45° field of view: 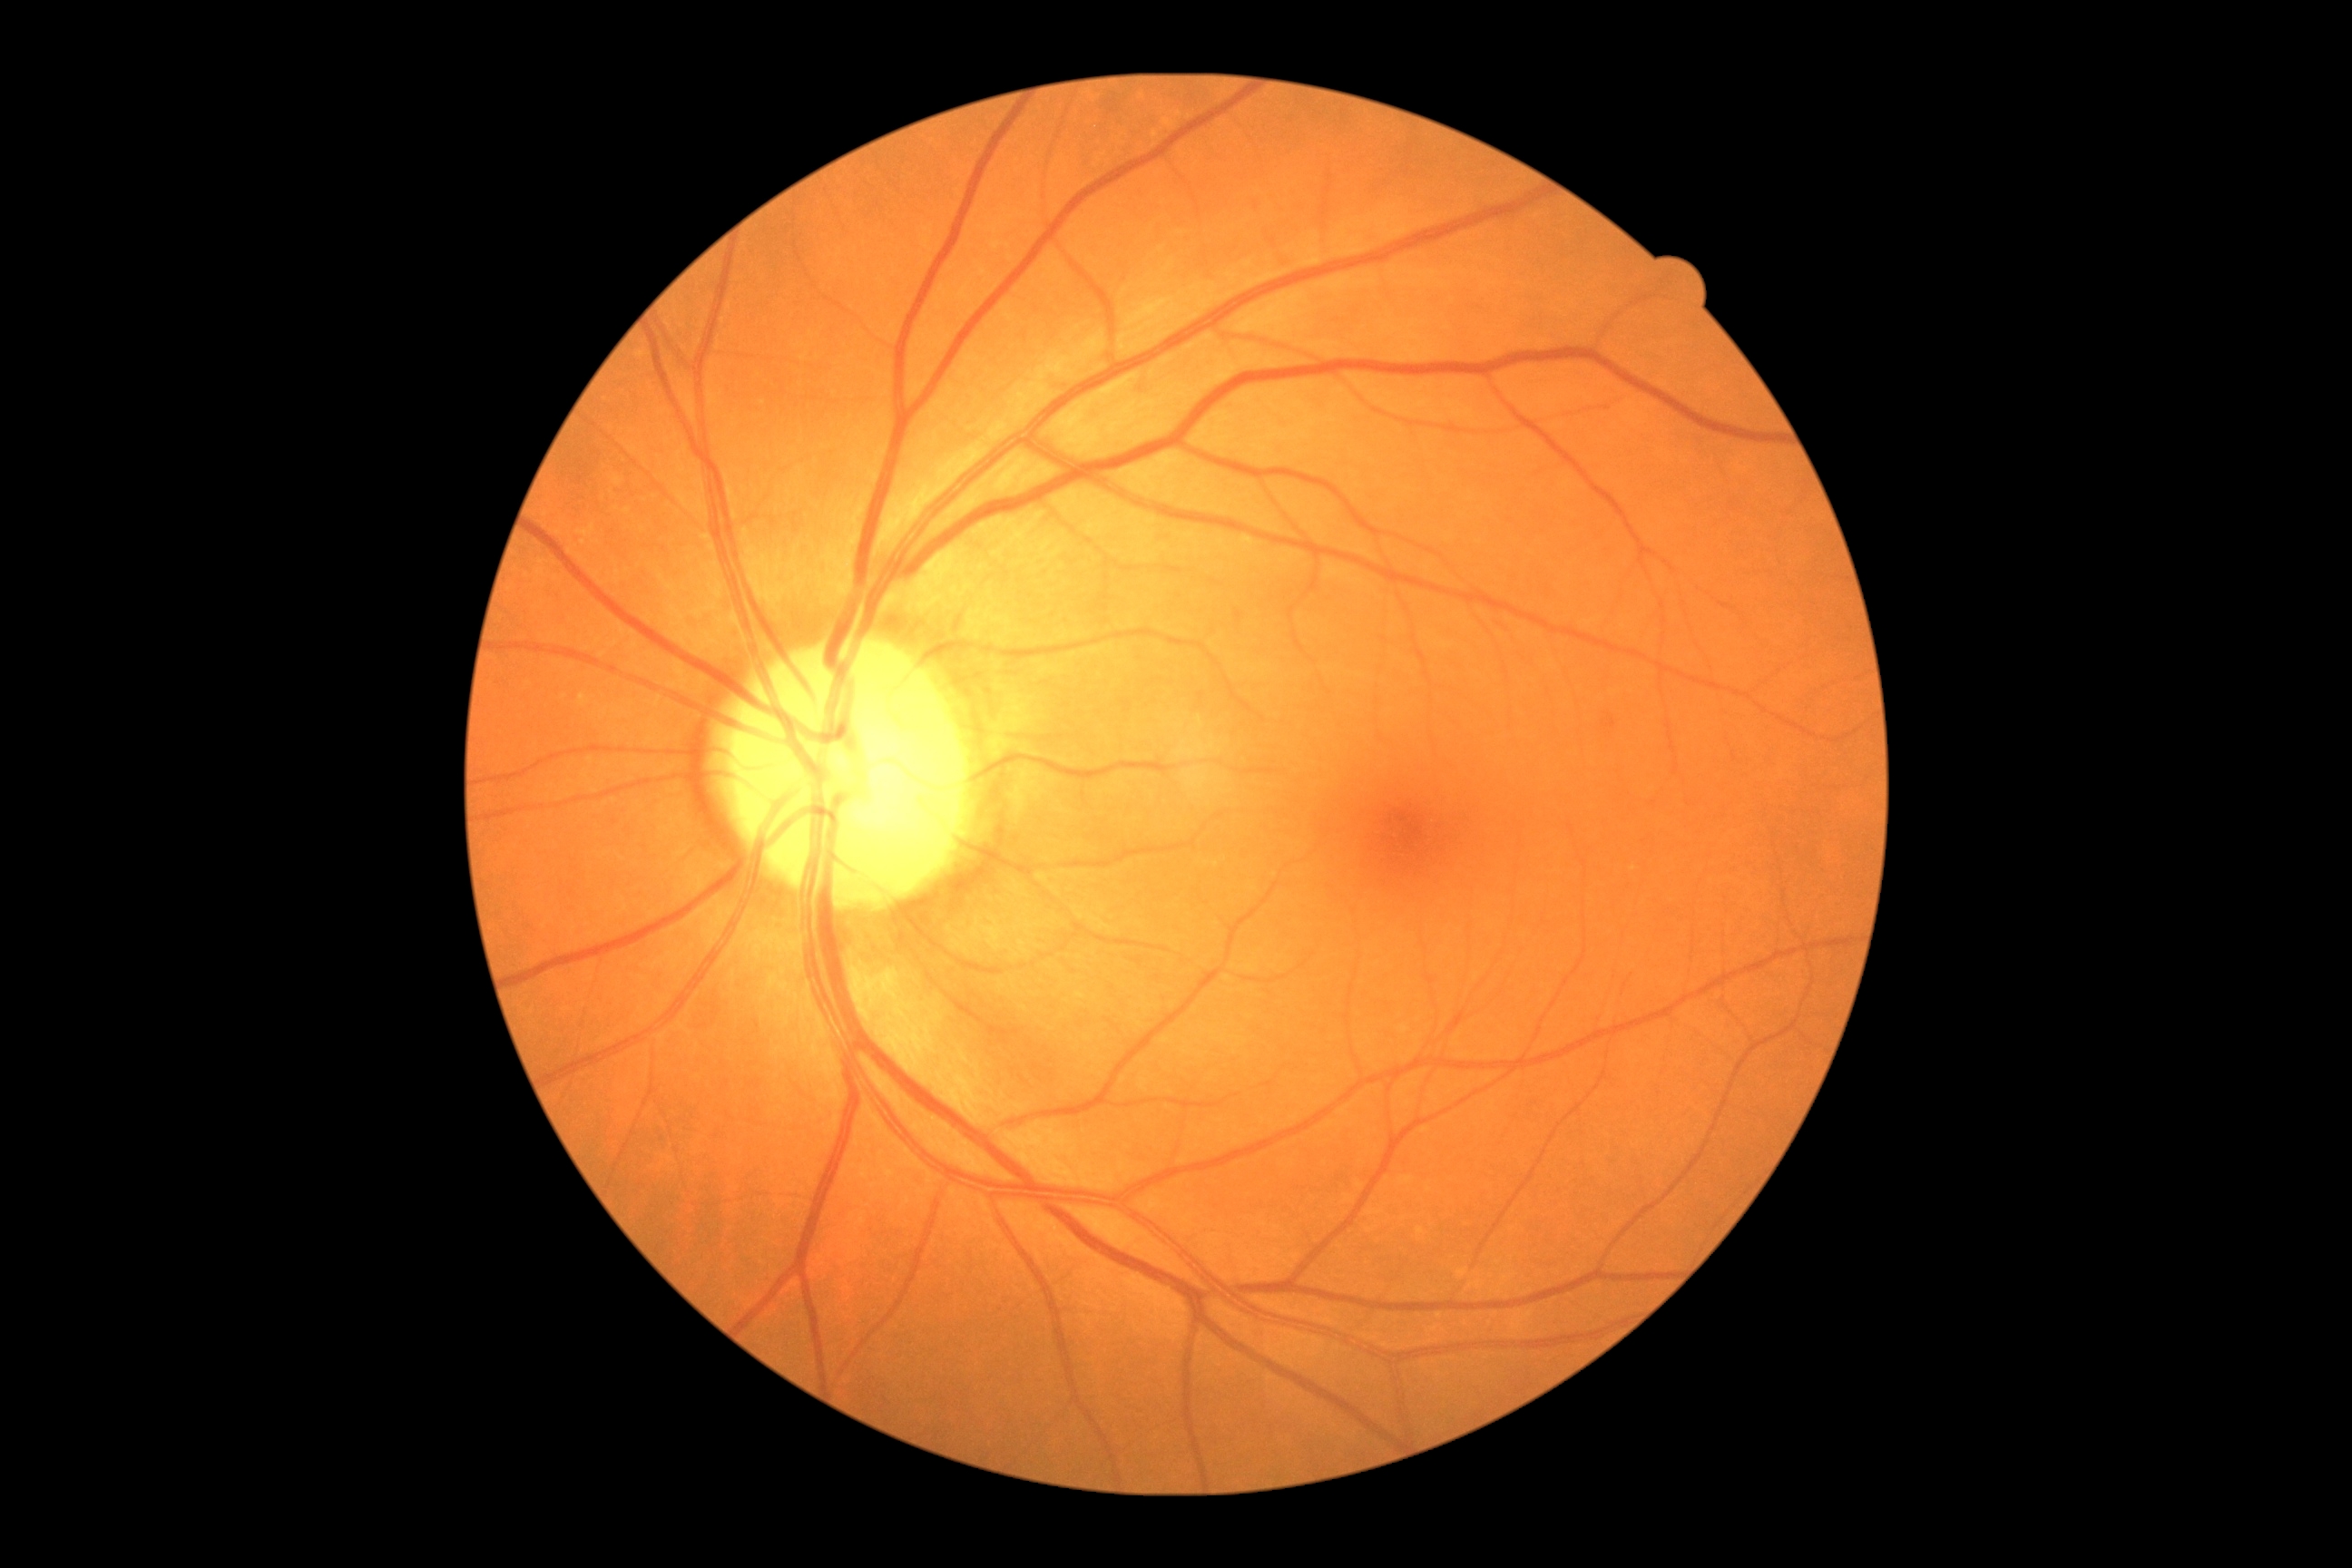
DR impression: negative for DR
diabetic retinopathy (DR): 0/4